1920 by 1440 pixels · Bosch handheld camera.
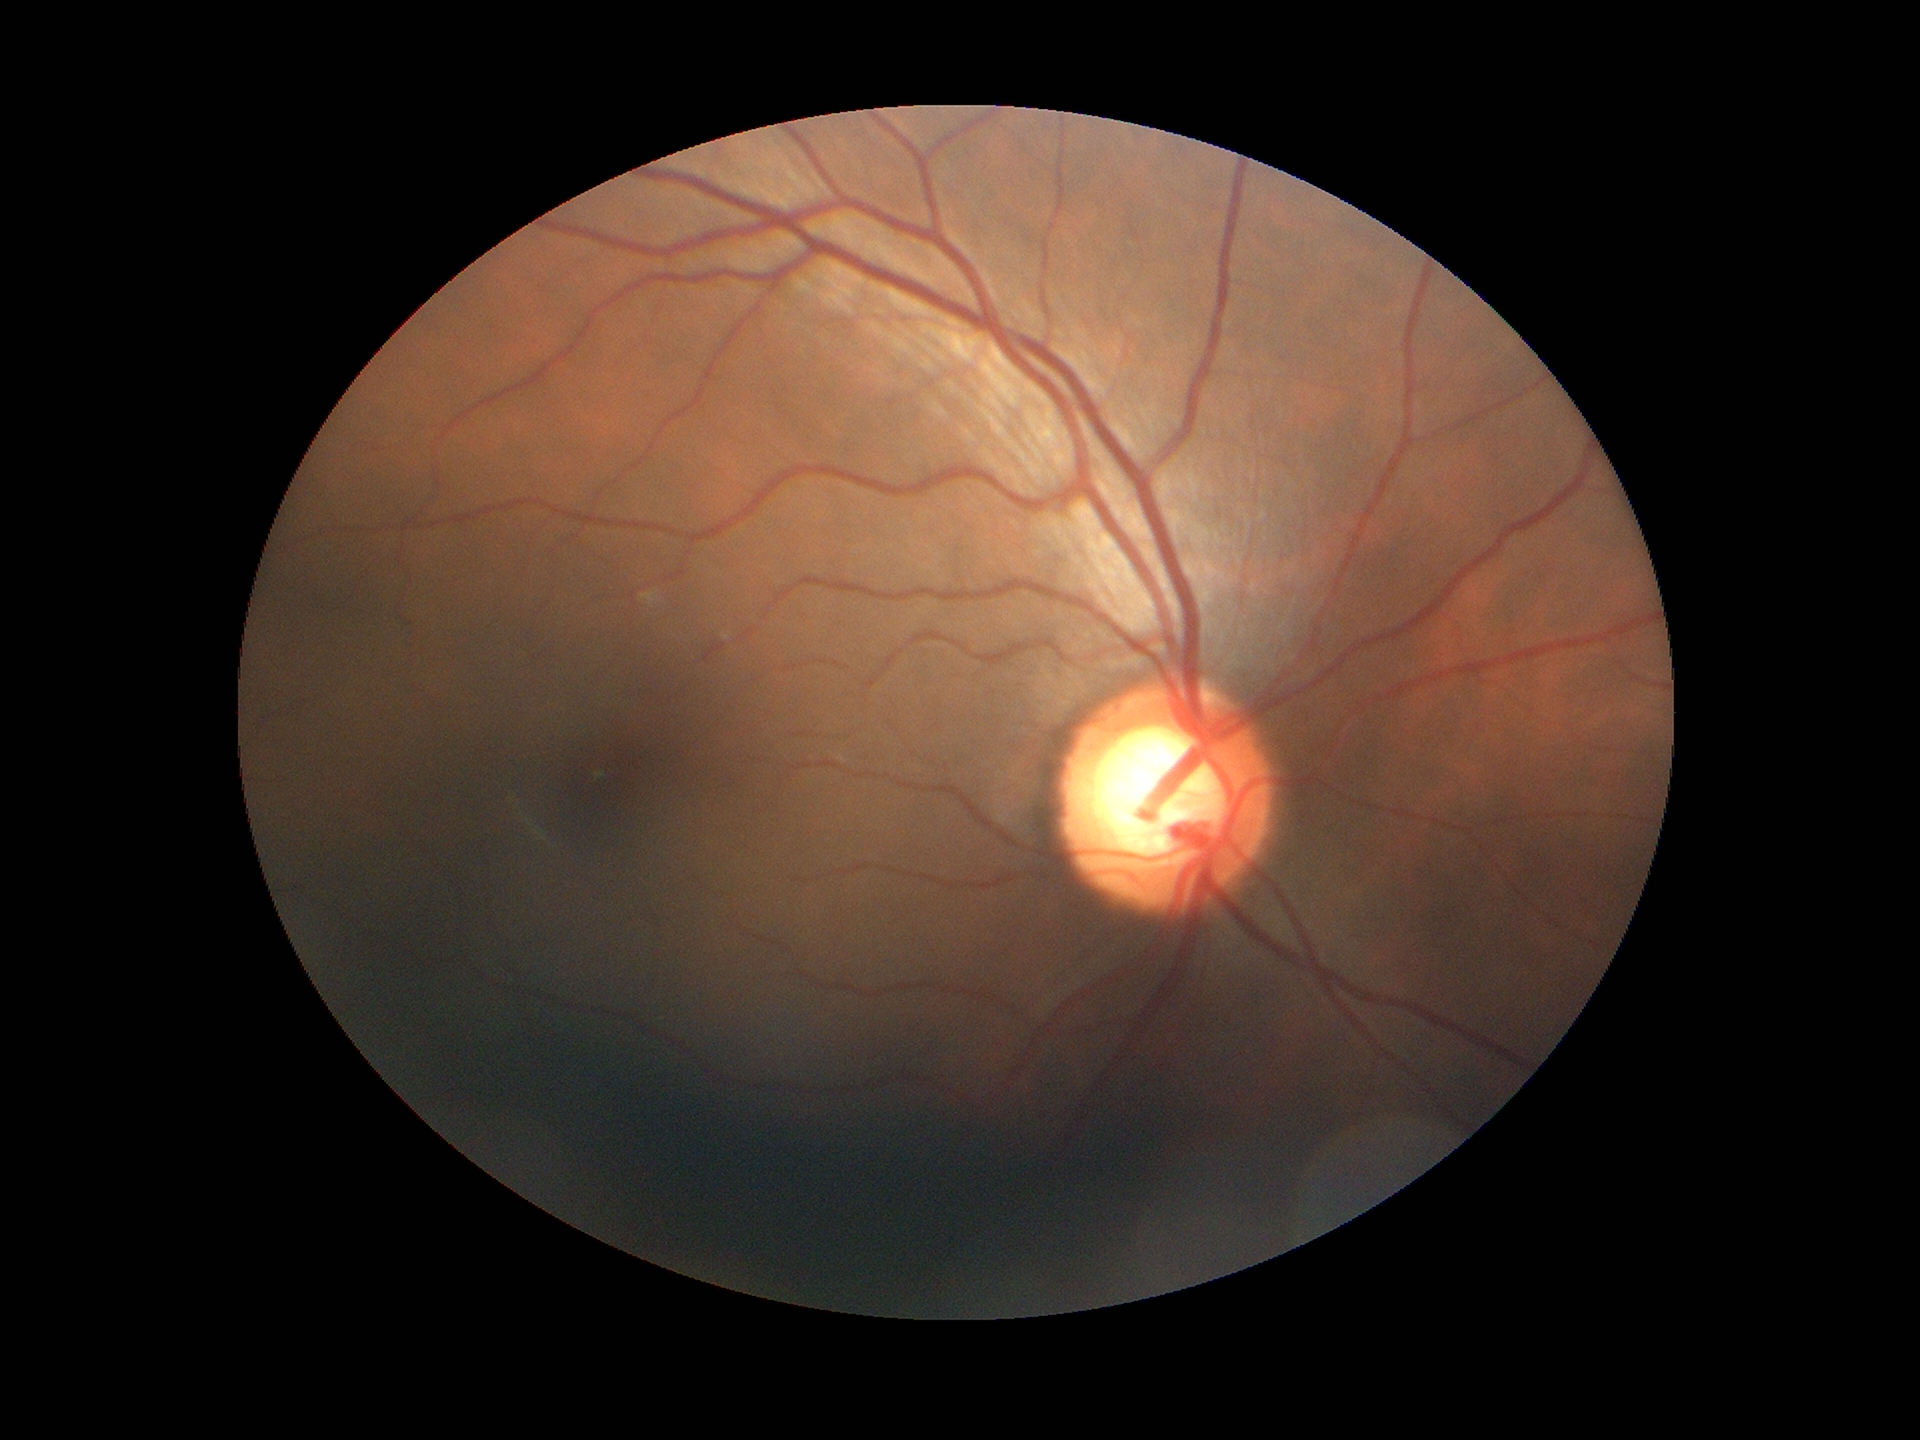 Vertical C/D ratio of 0.61. Glaucoma impression: suspect (3 of 5 graders flagged glaucoma suspect).